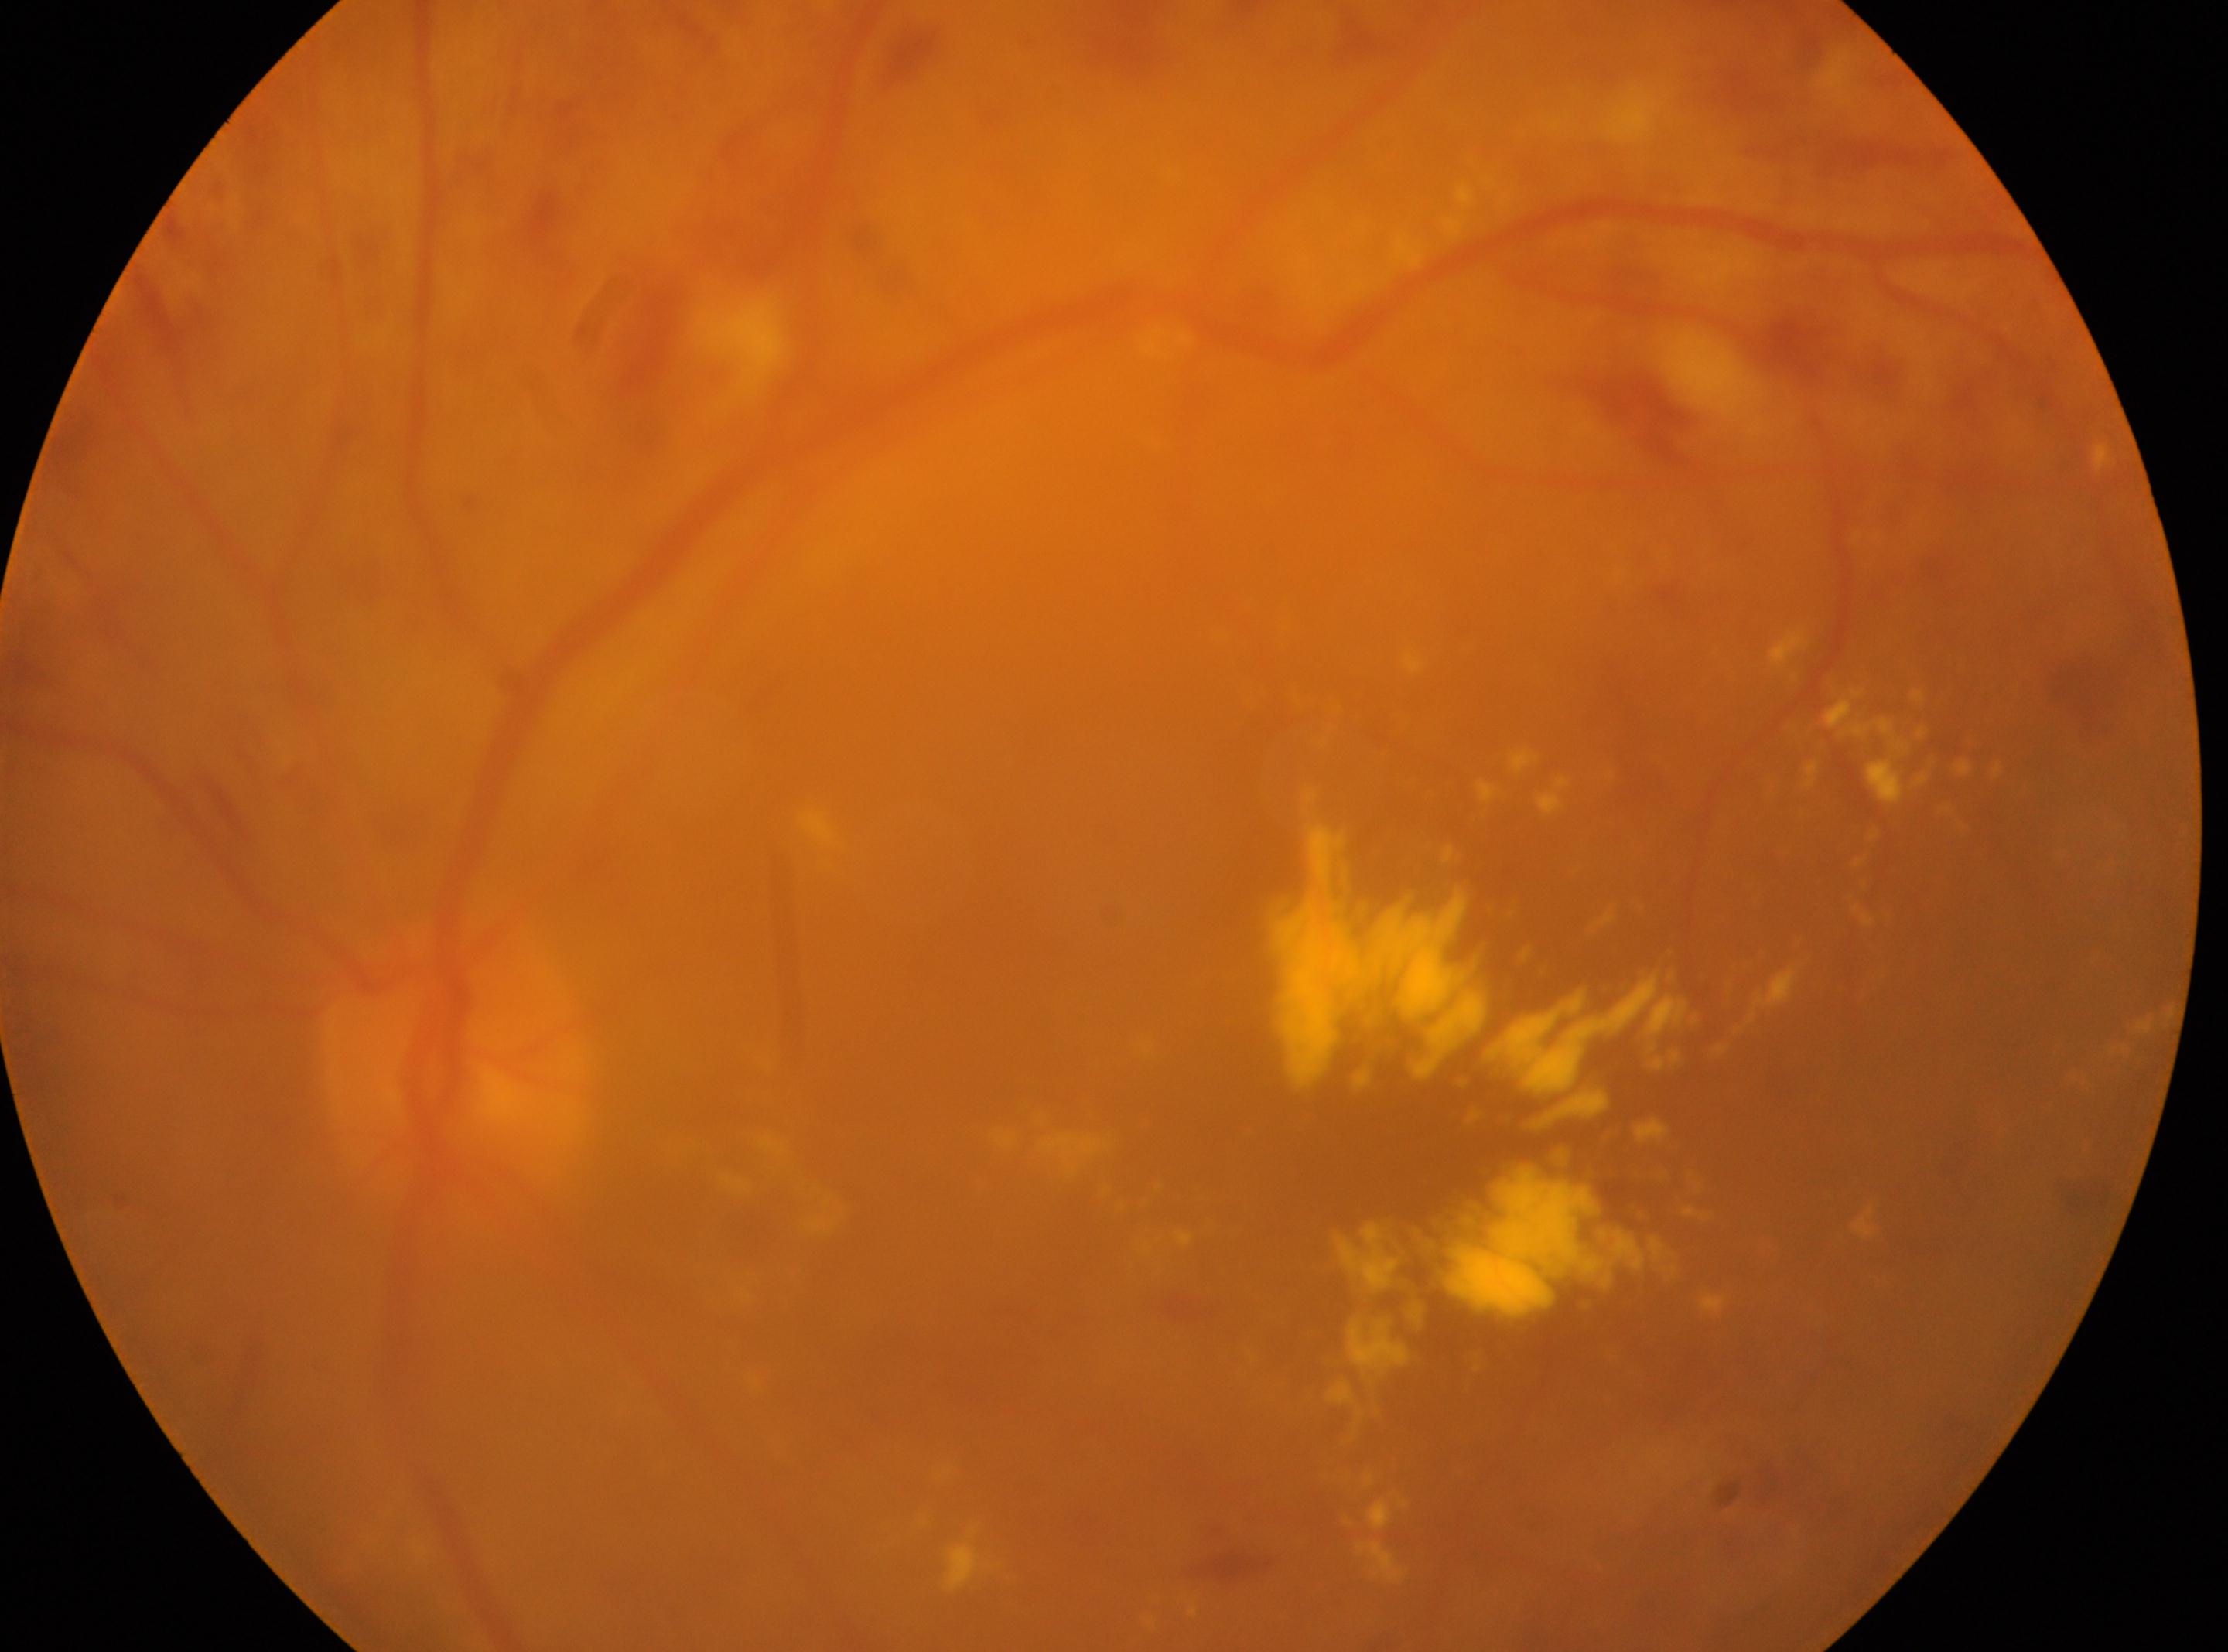 Diabetic retinopathy (DR): grade 2. Imaged eye: left eye. Optic disc located at 453px, 1070px. Fovea center: 1315px, 1169px.